Image size 240x240; retinal fundus photograph — 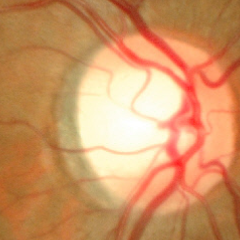
No glaucomatous changes.